Color fundus photograph. 1932 by 1932 pixels
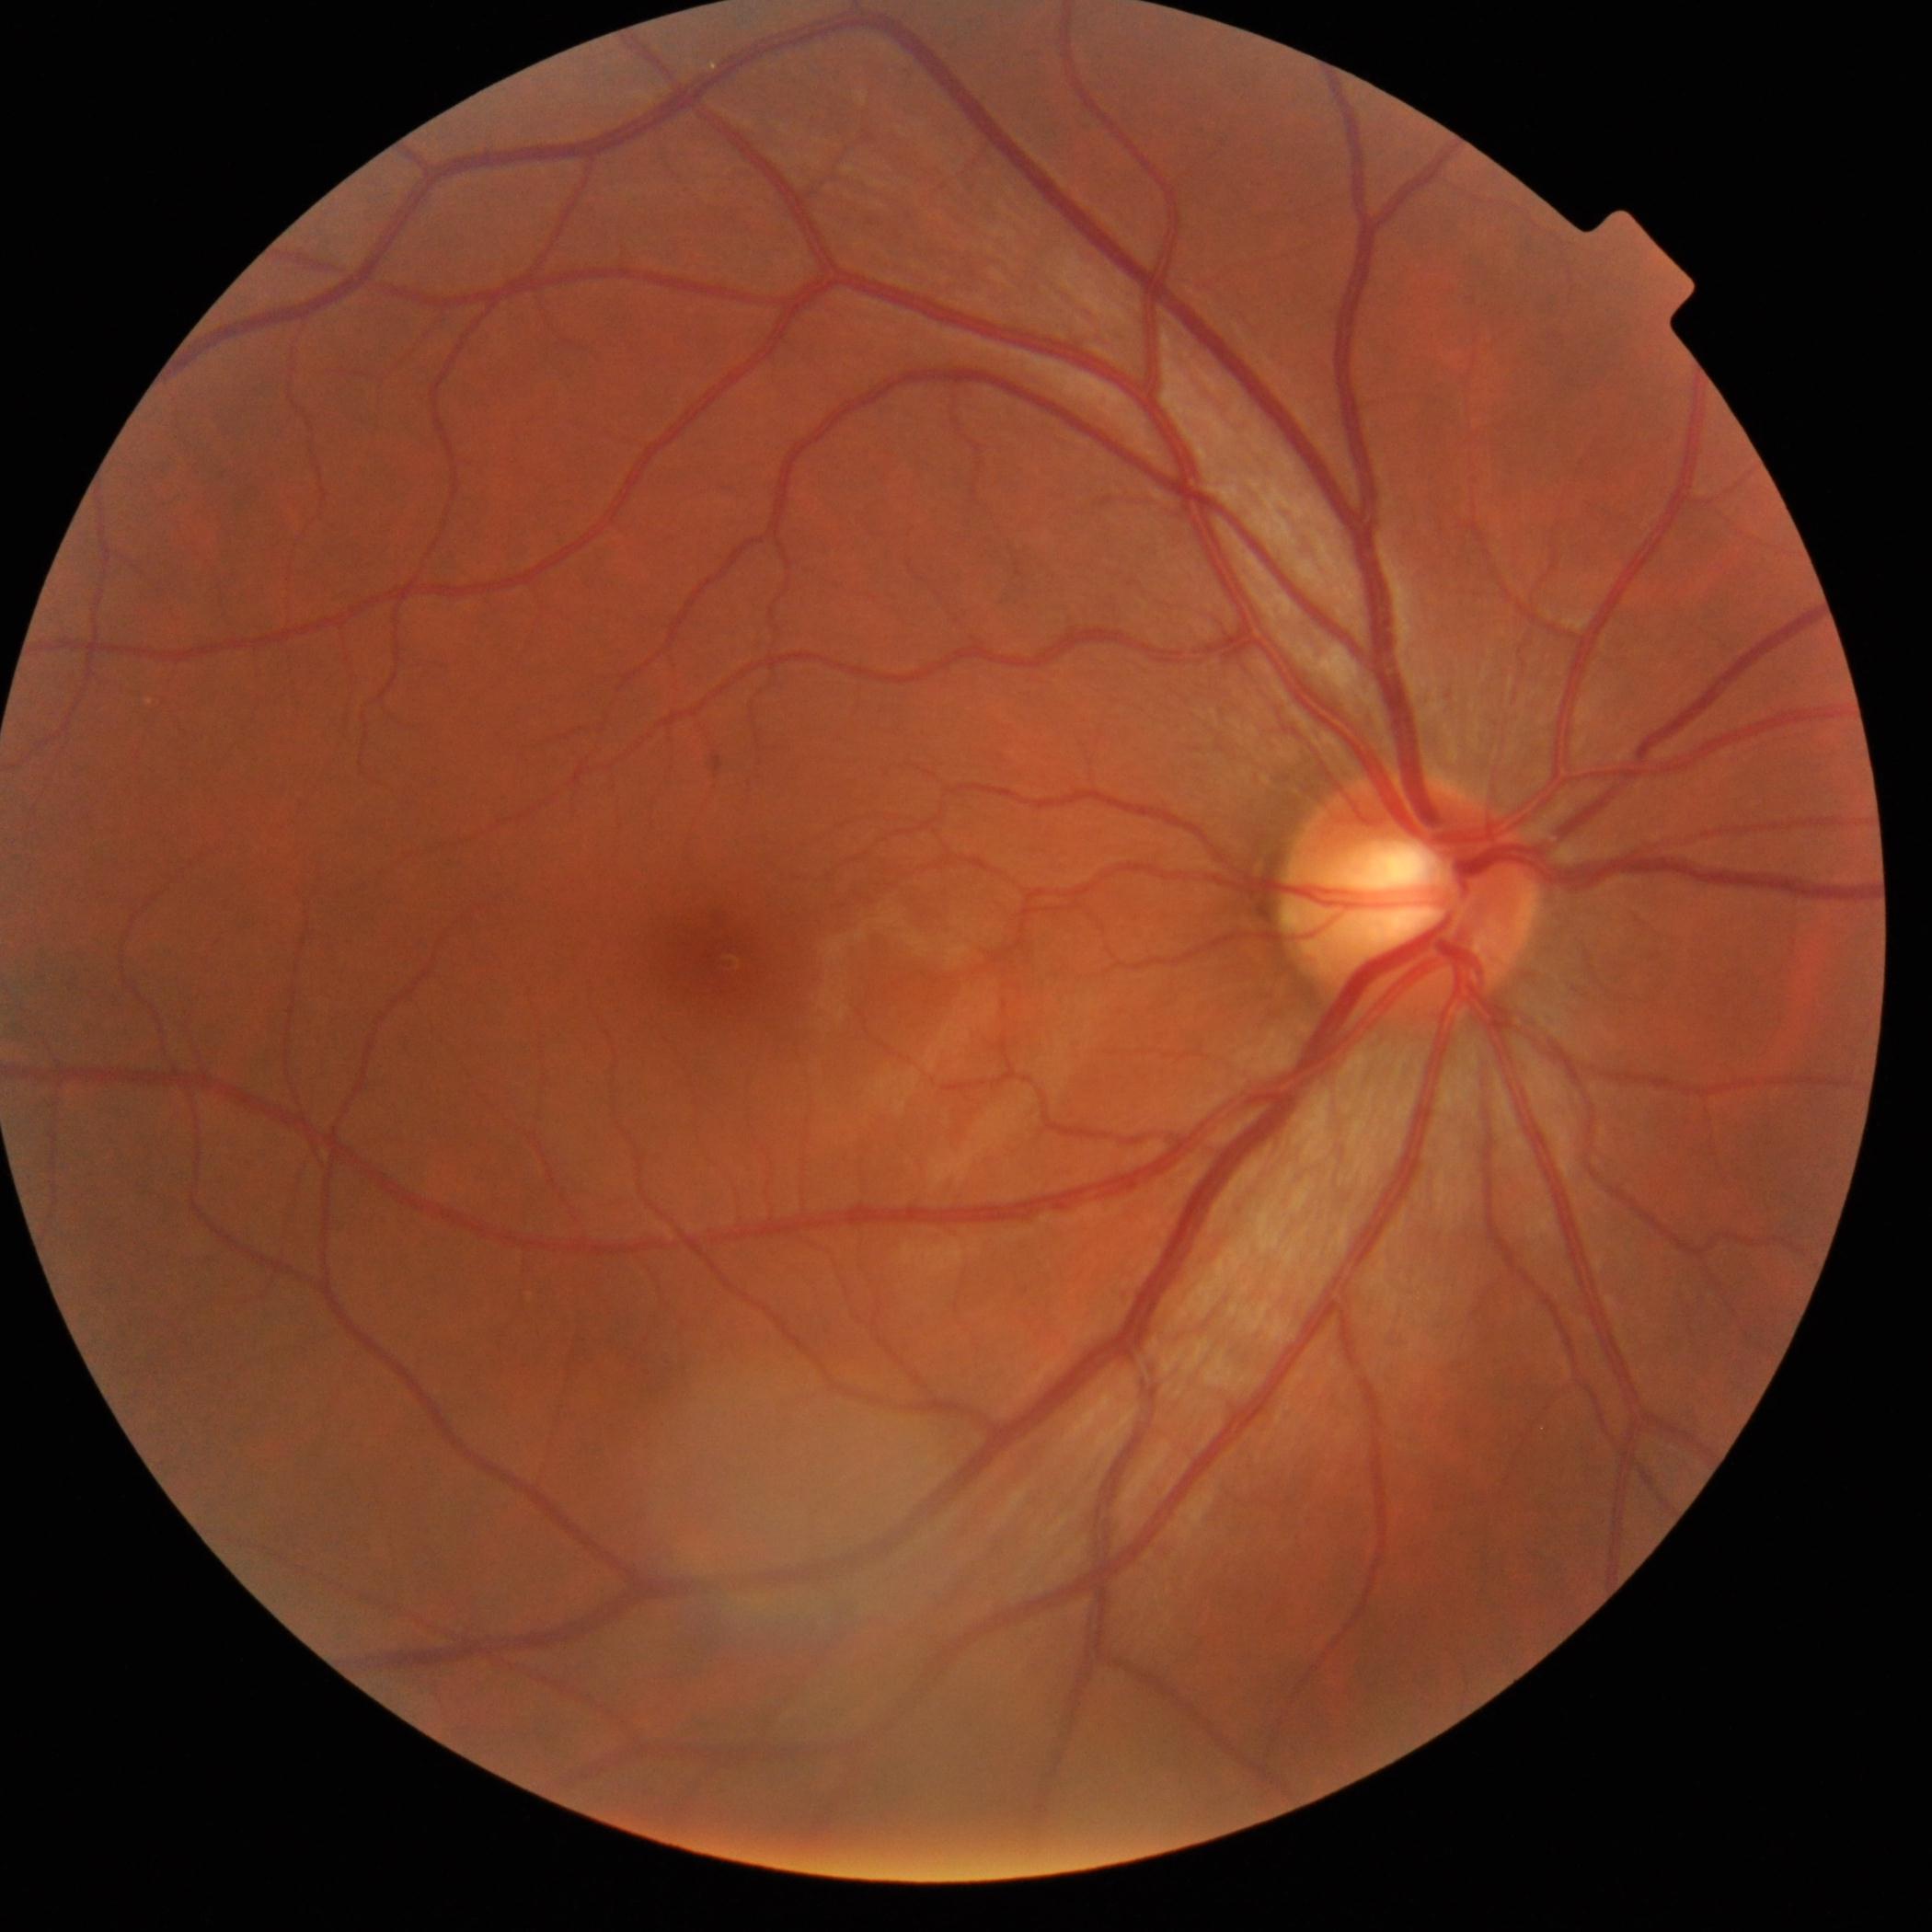

retinopathy = no apparent retinopathy (grade 0)